FOV: 45 degrees.
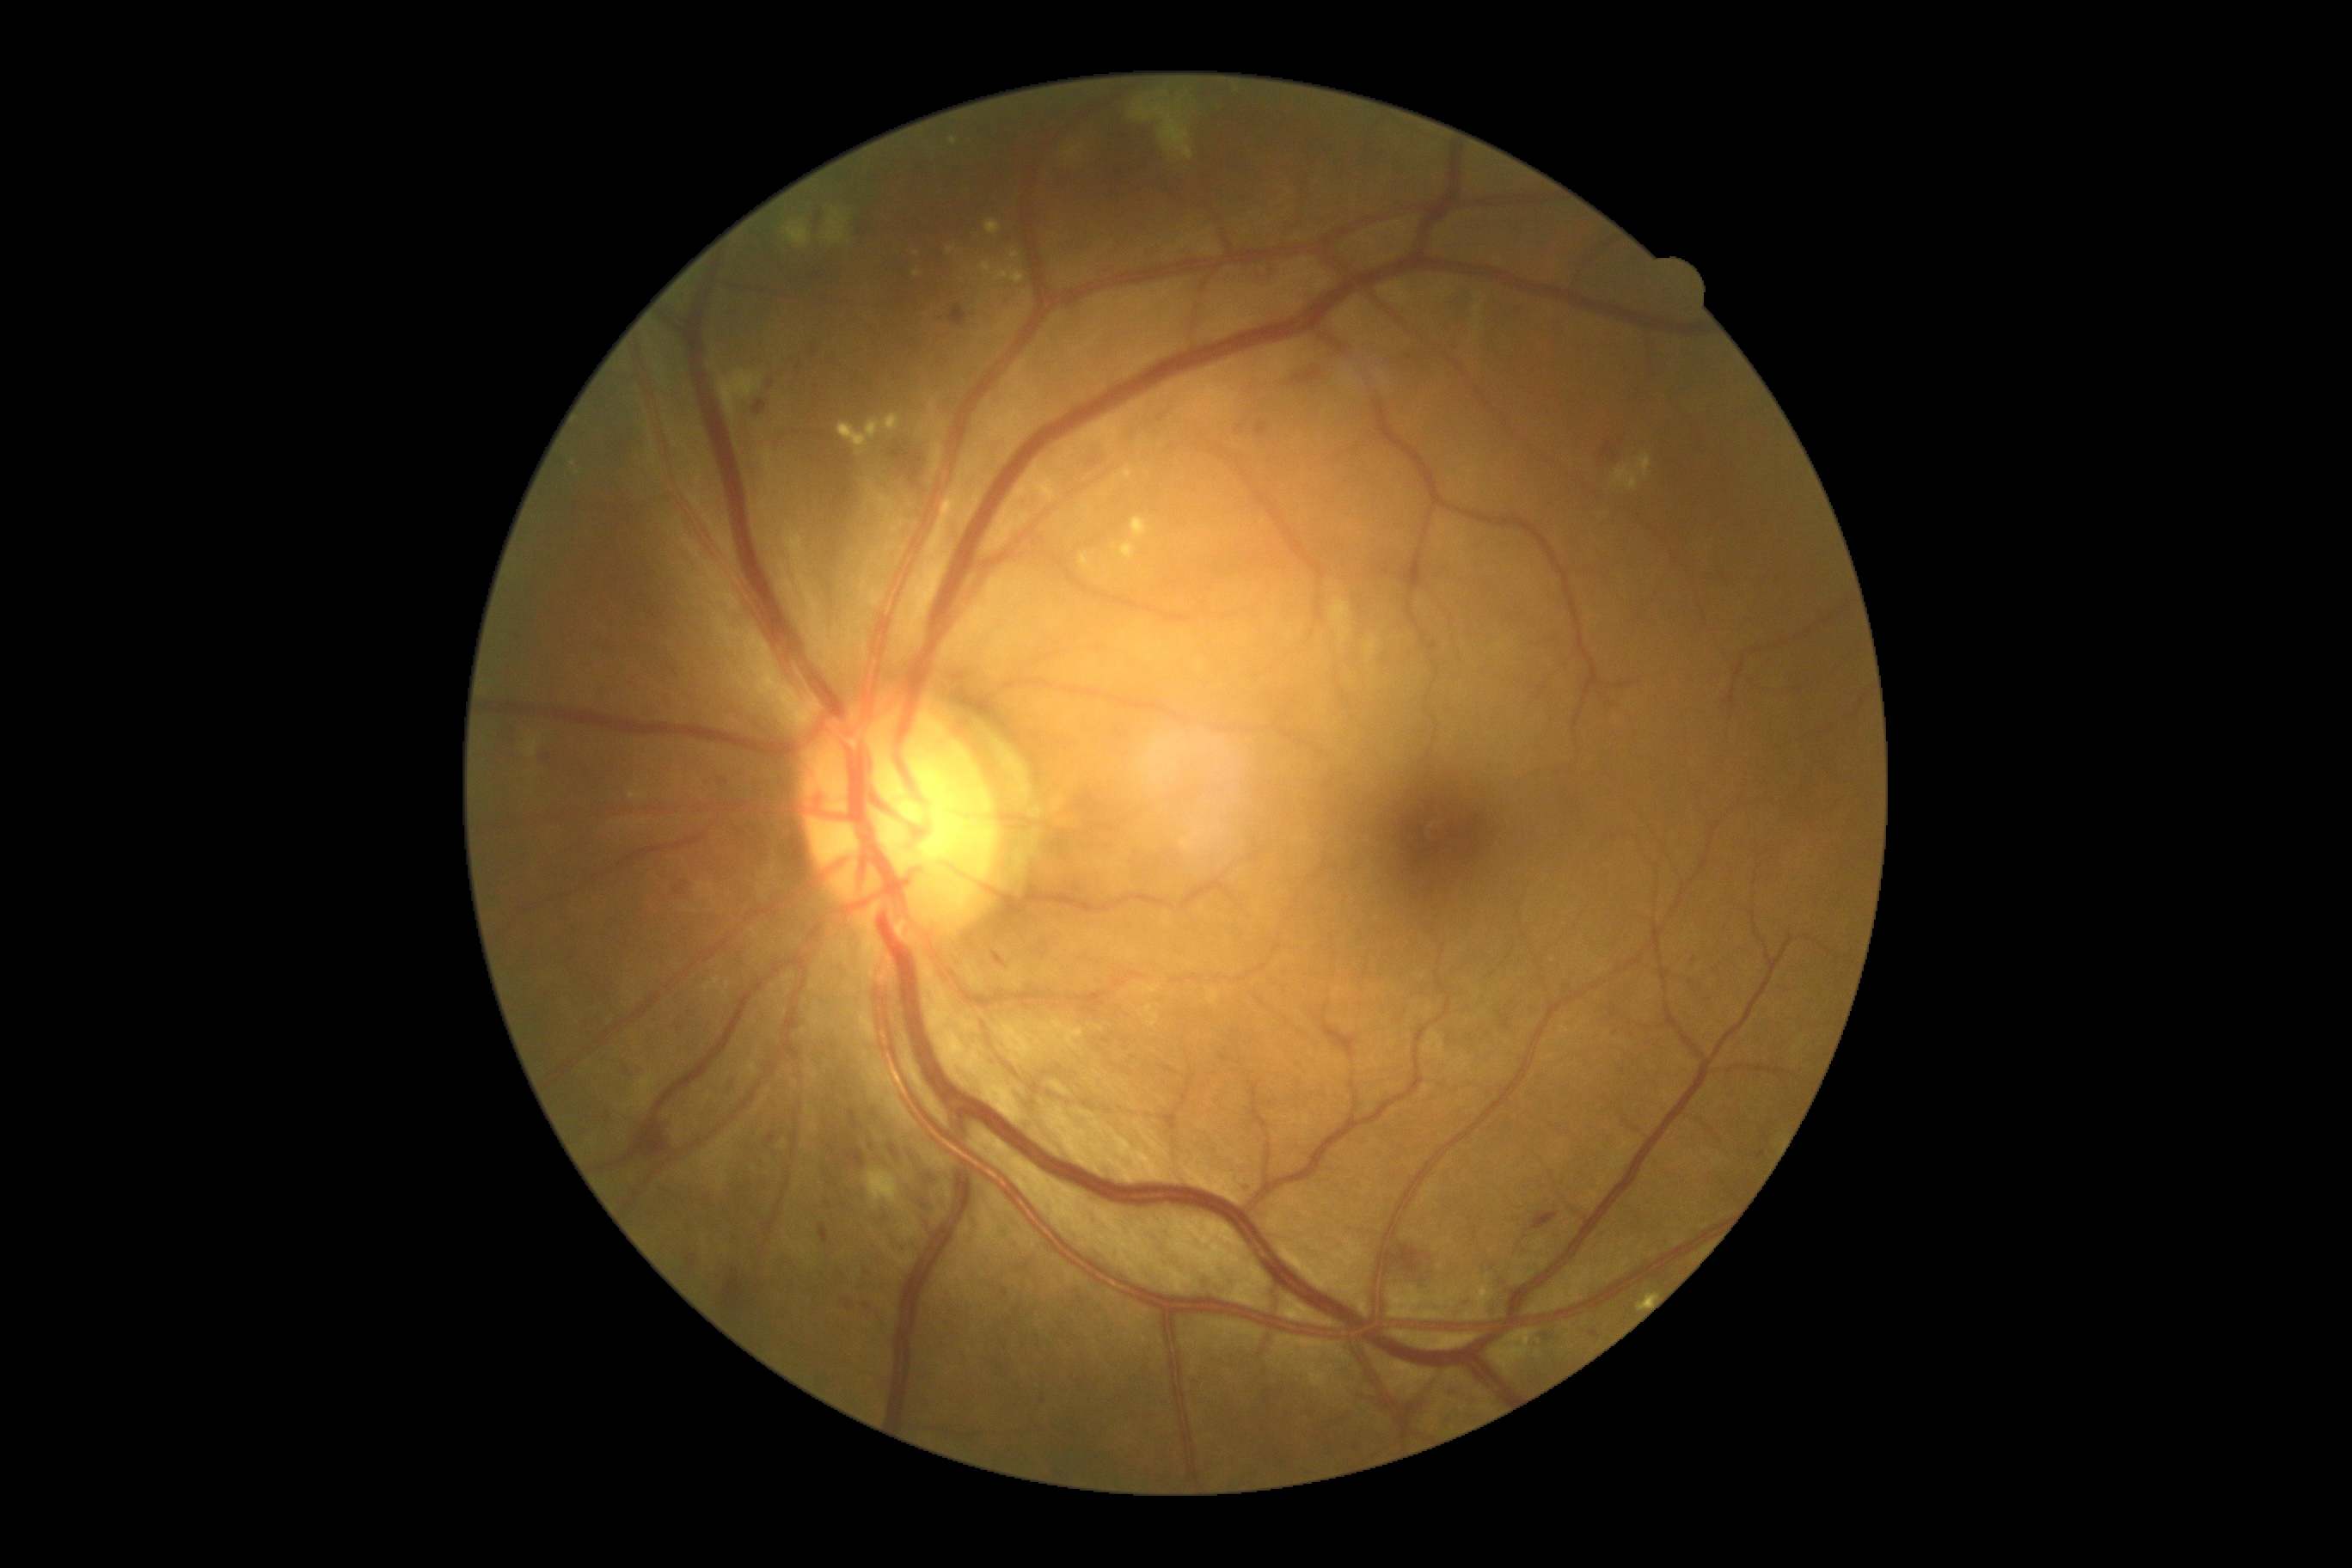
DR grade is 2 (moderate NPDR).